FOV: 45 degrees; fundus photo:
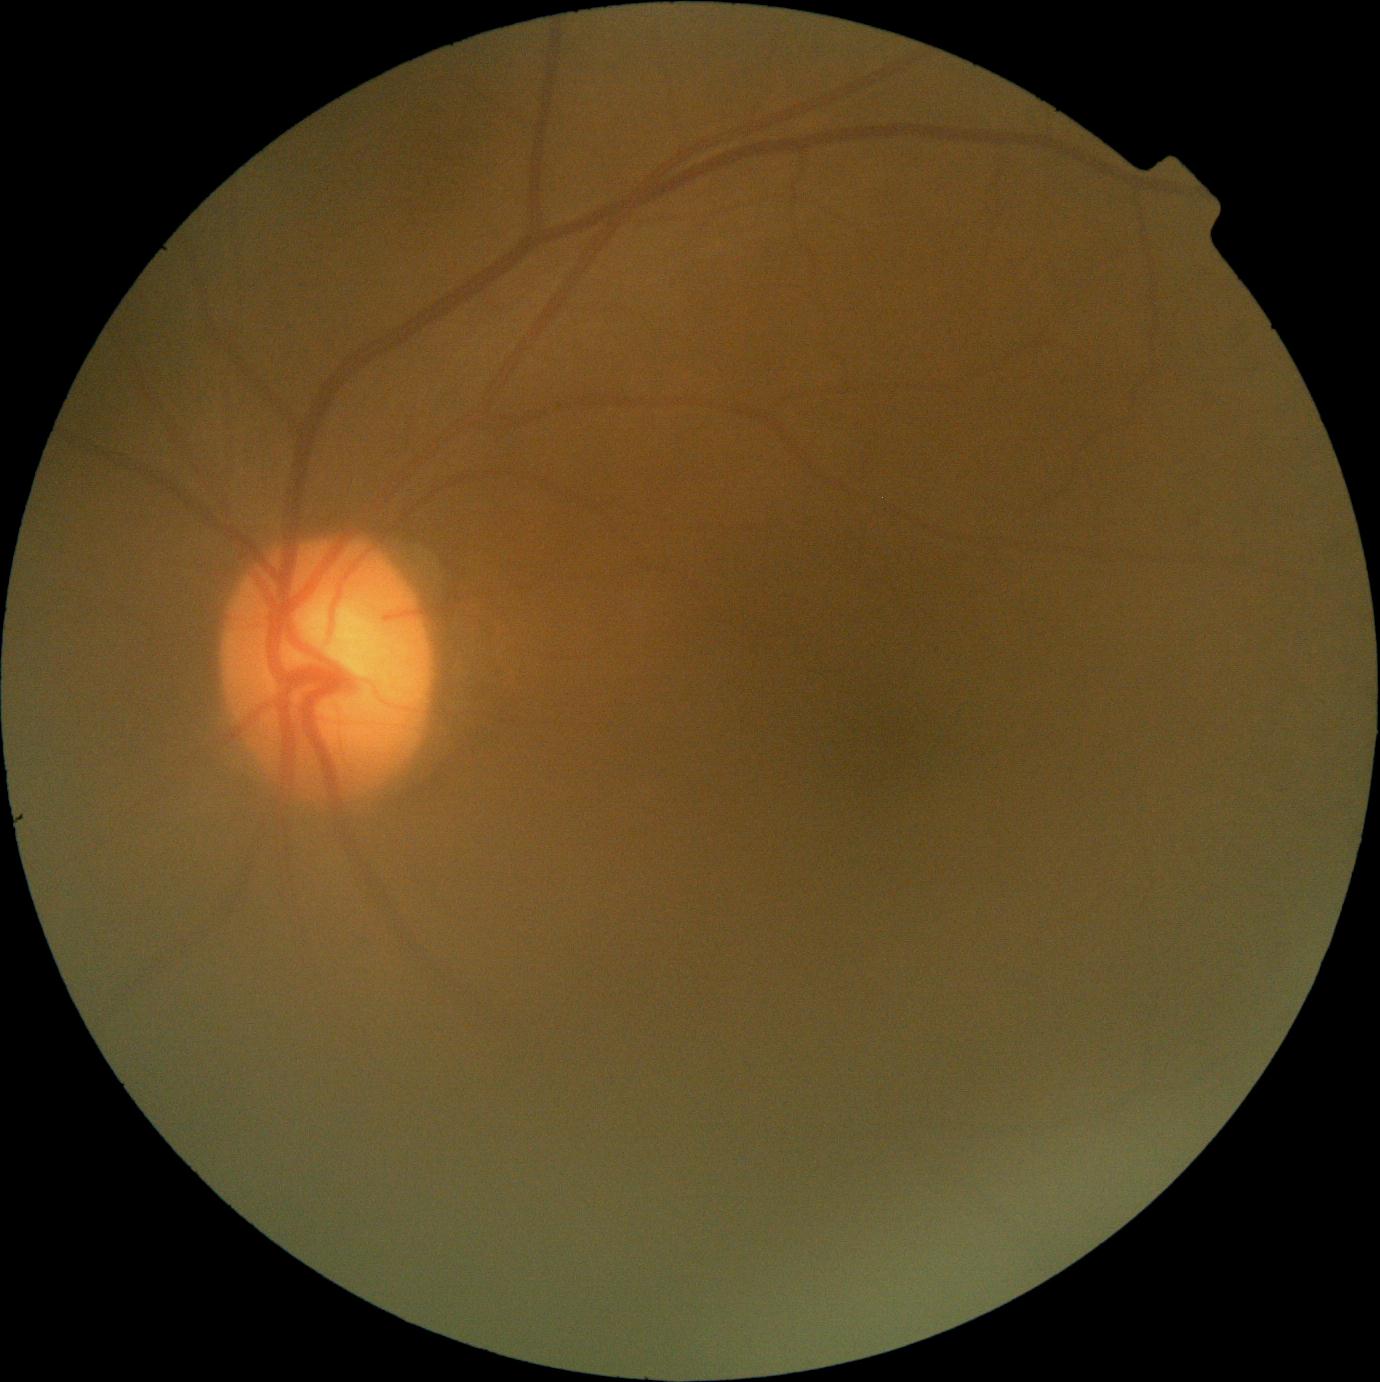

DR grade@0 (no apparent retinopathy).